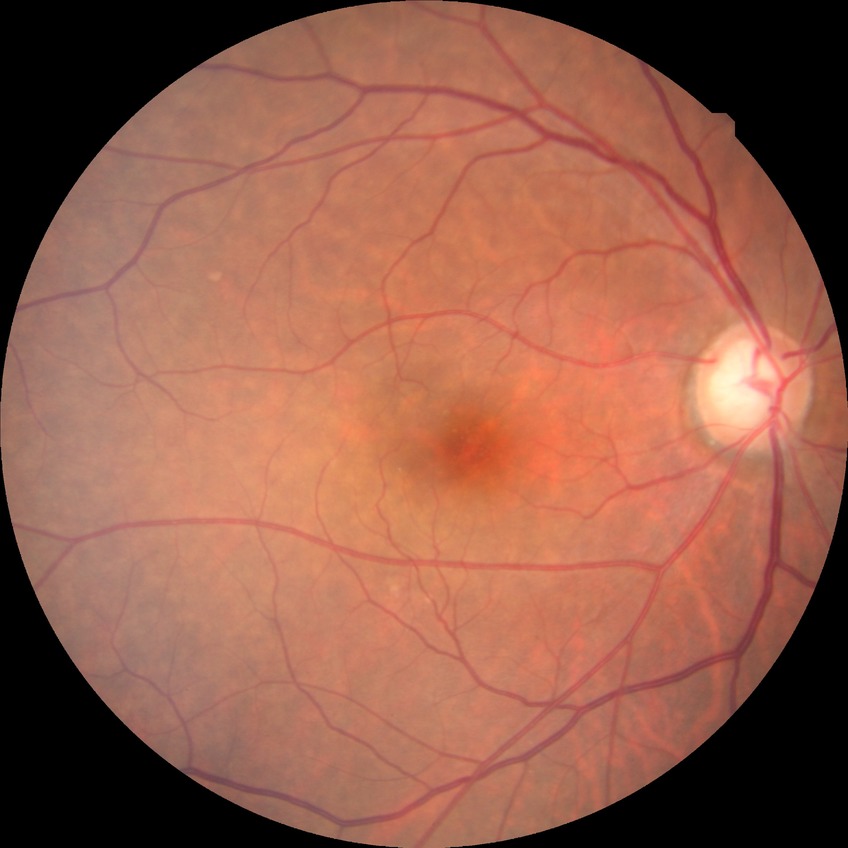
Davis DR grade: NDR. No DR findings.